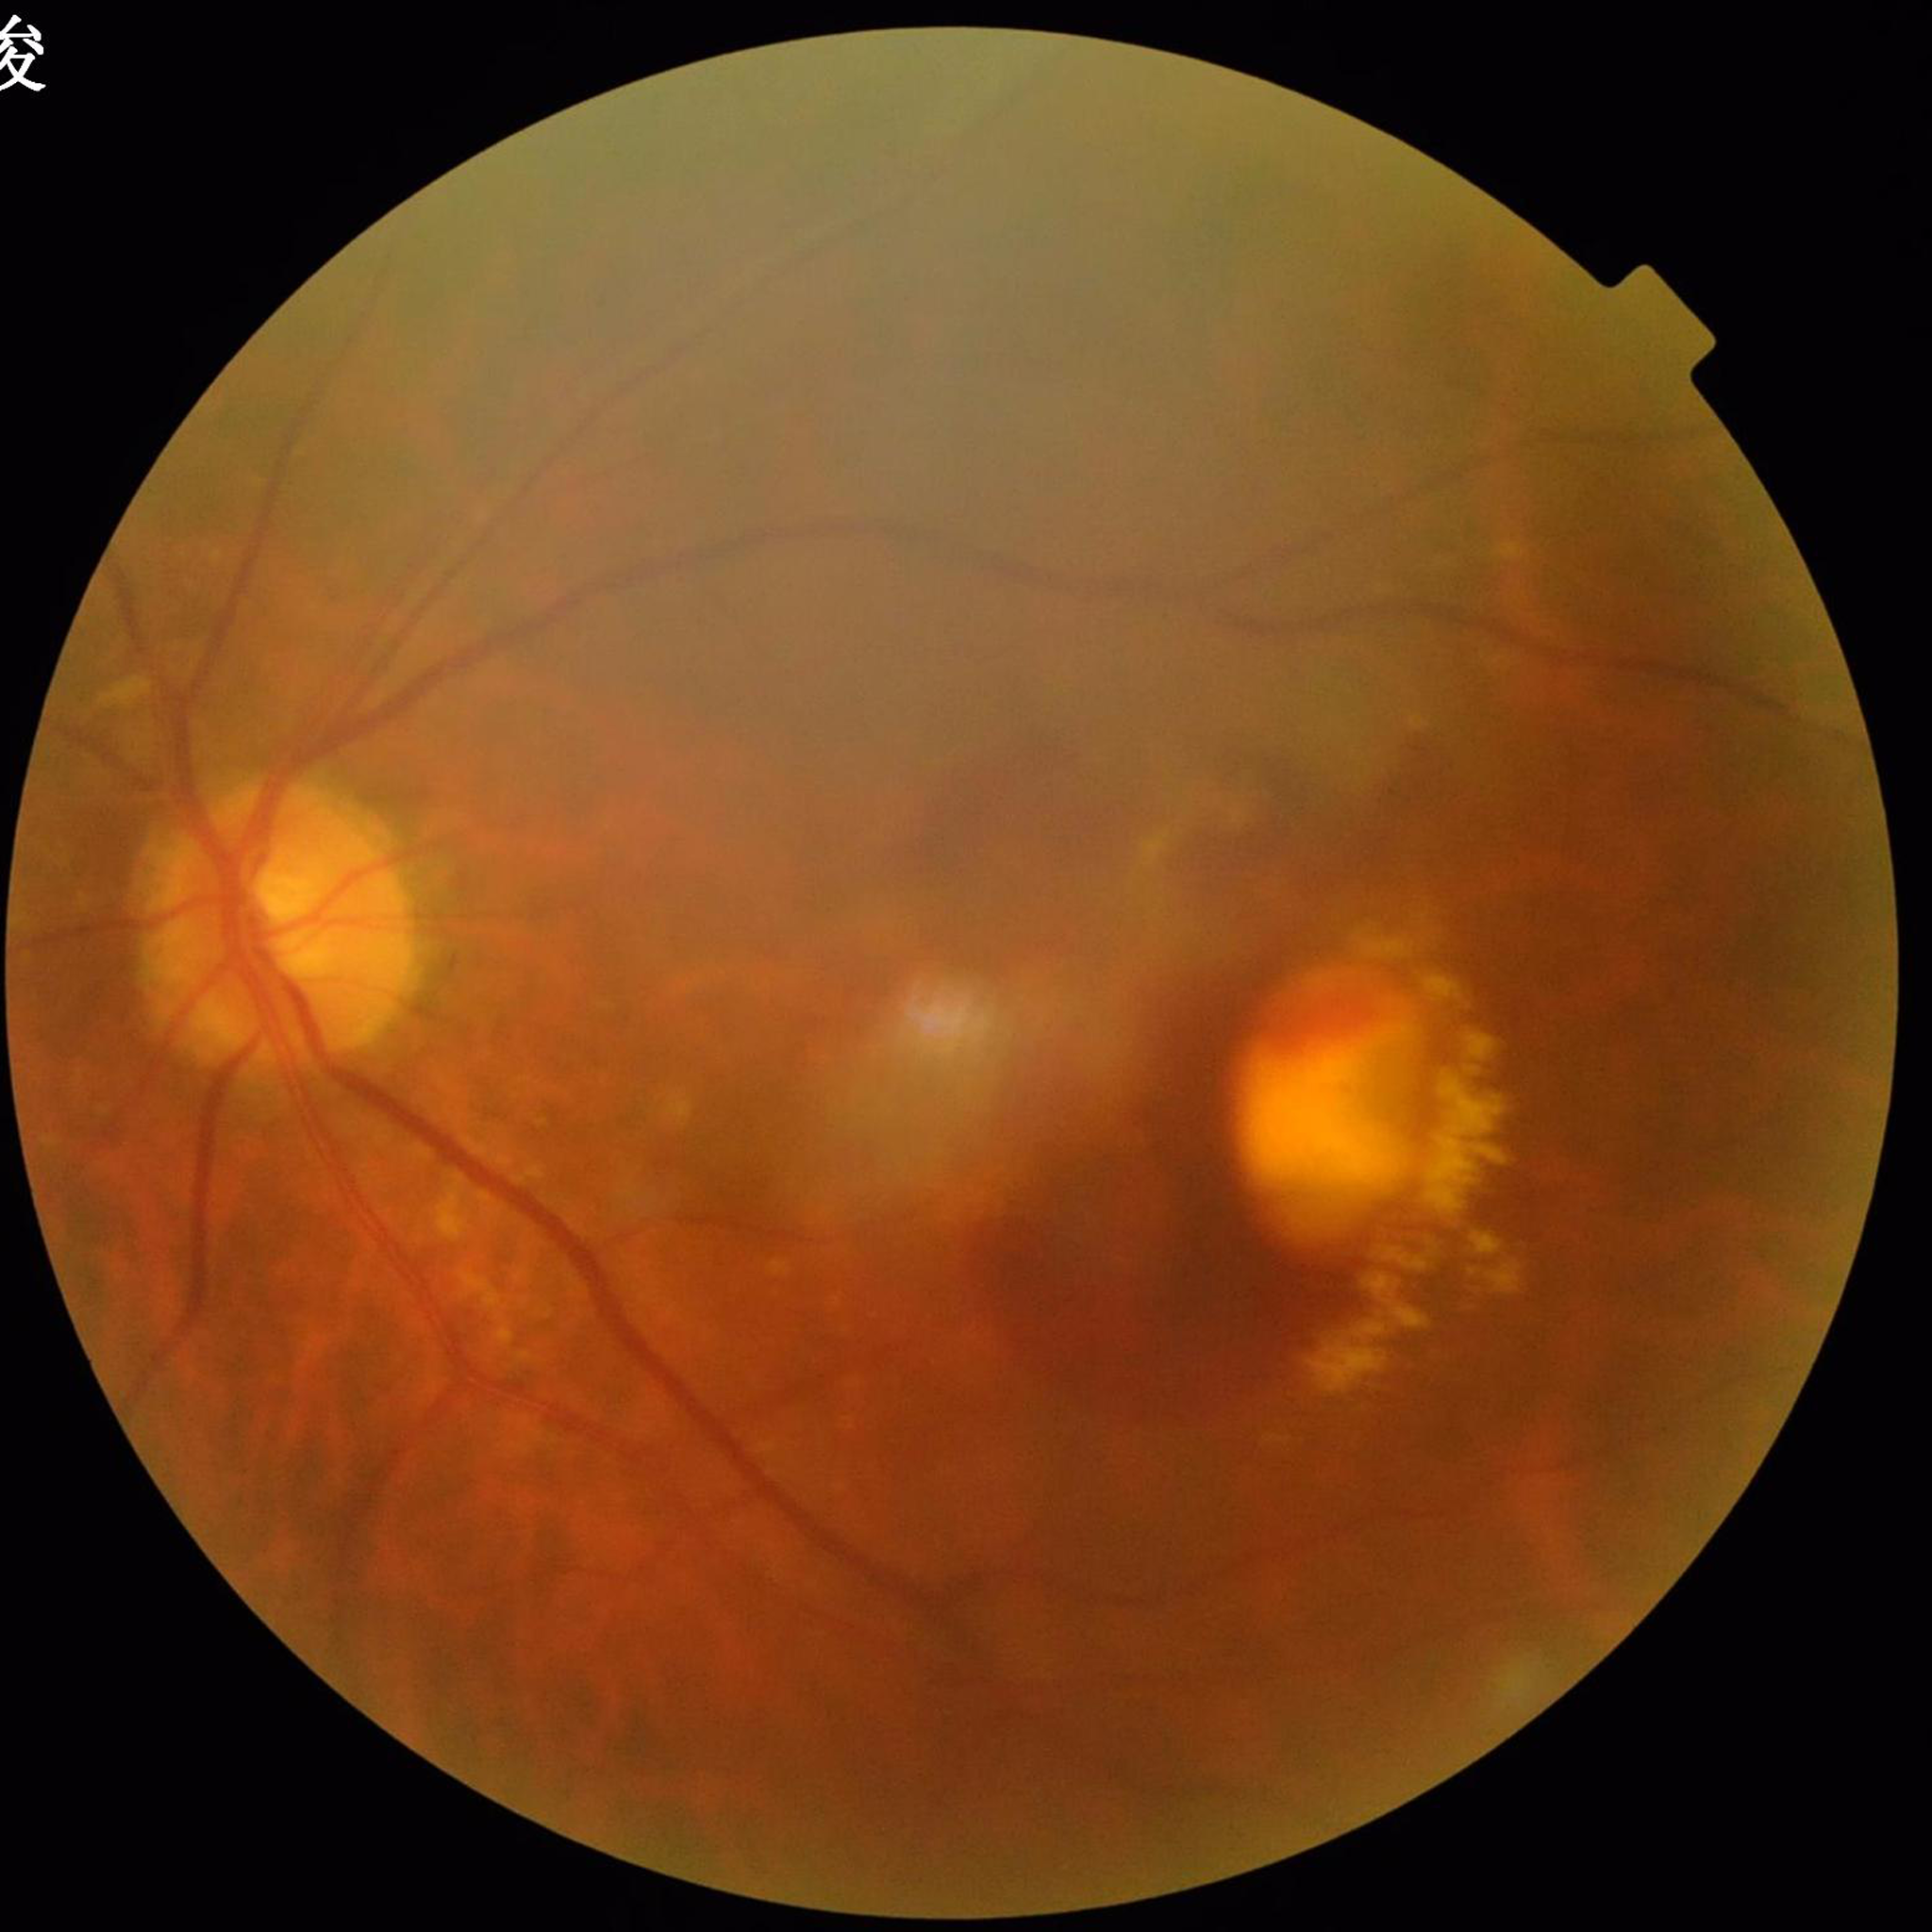
Diagnosed with age-related macular degeneration (AMD). Image quality: reduced — blur.